Color fundus image — 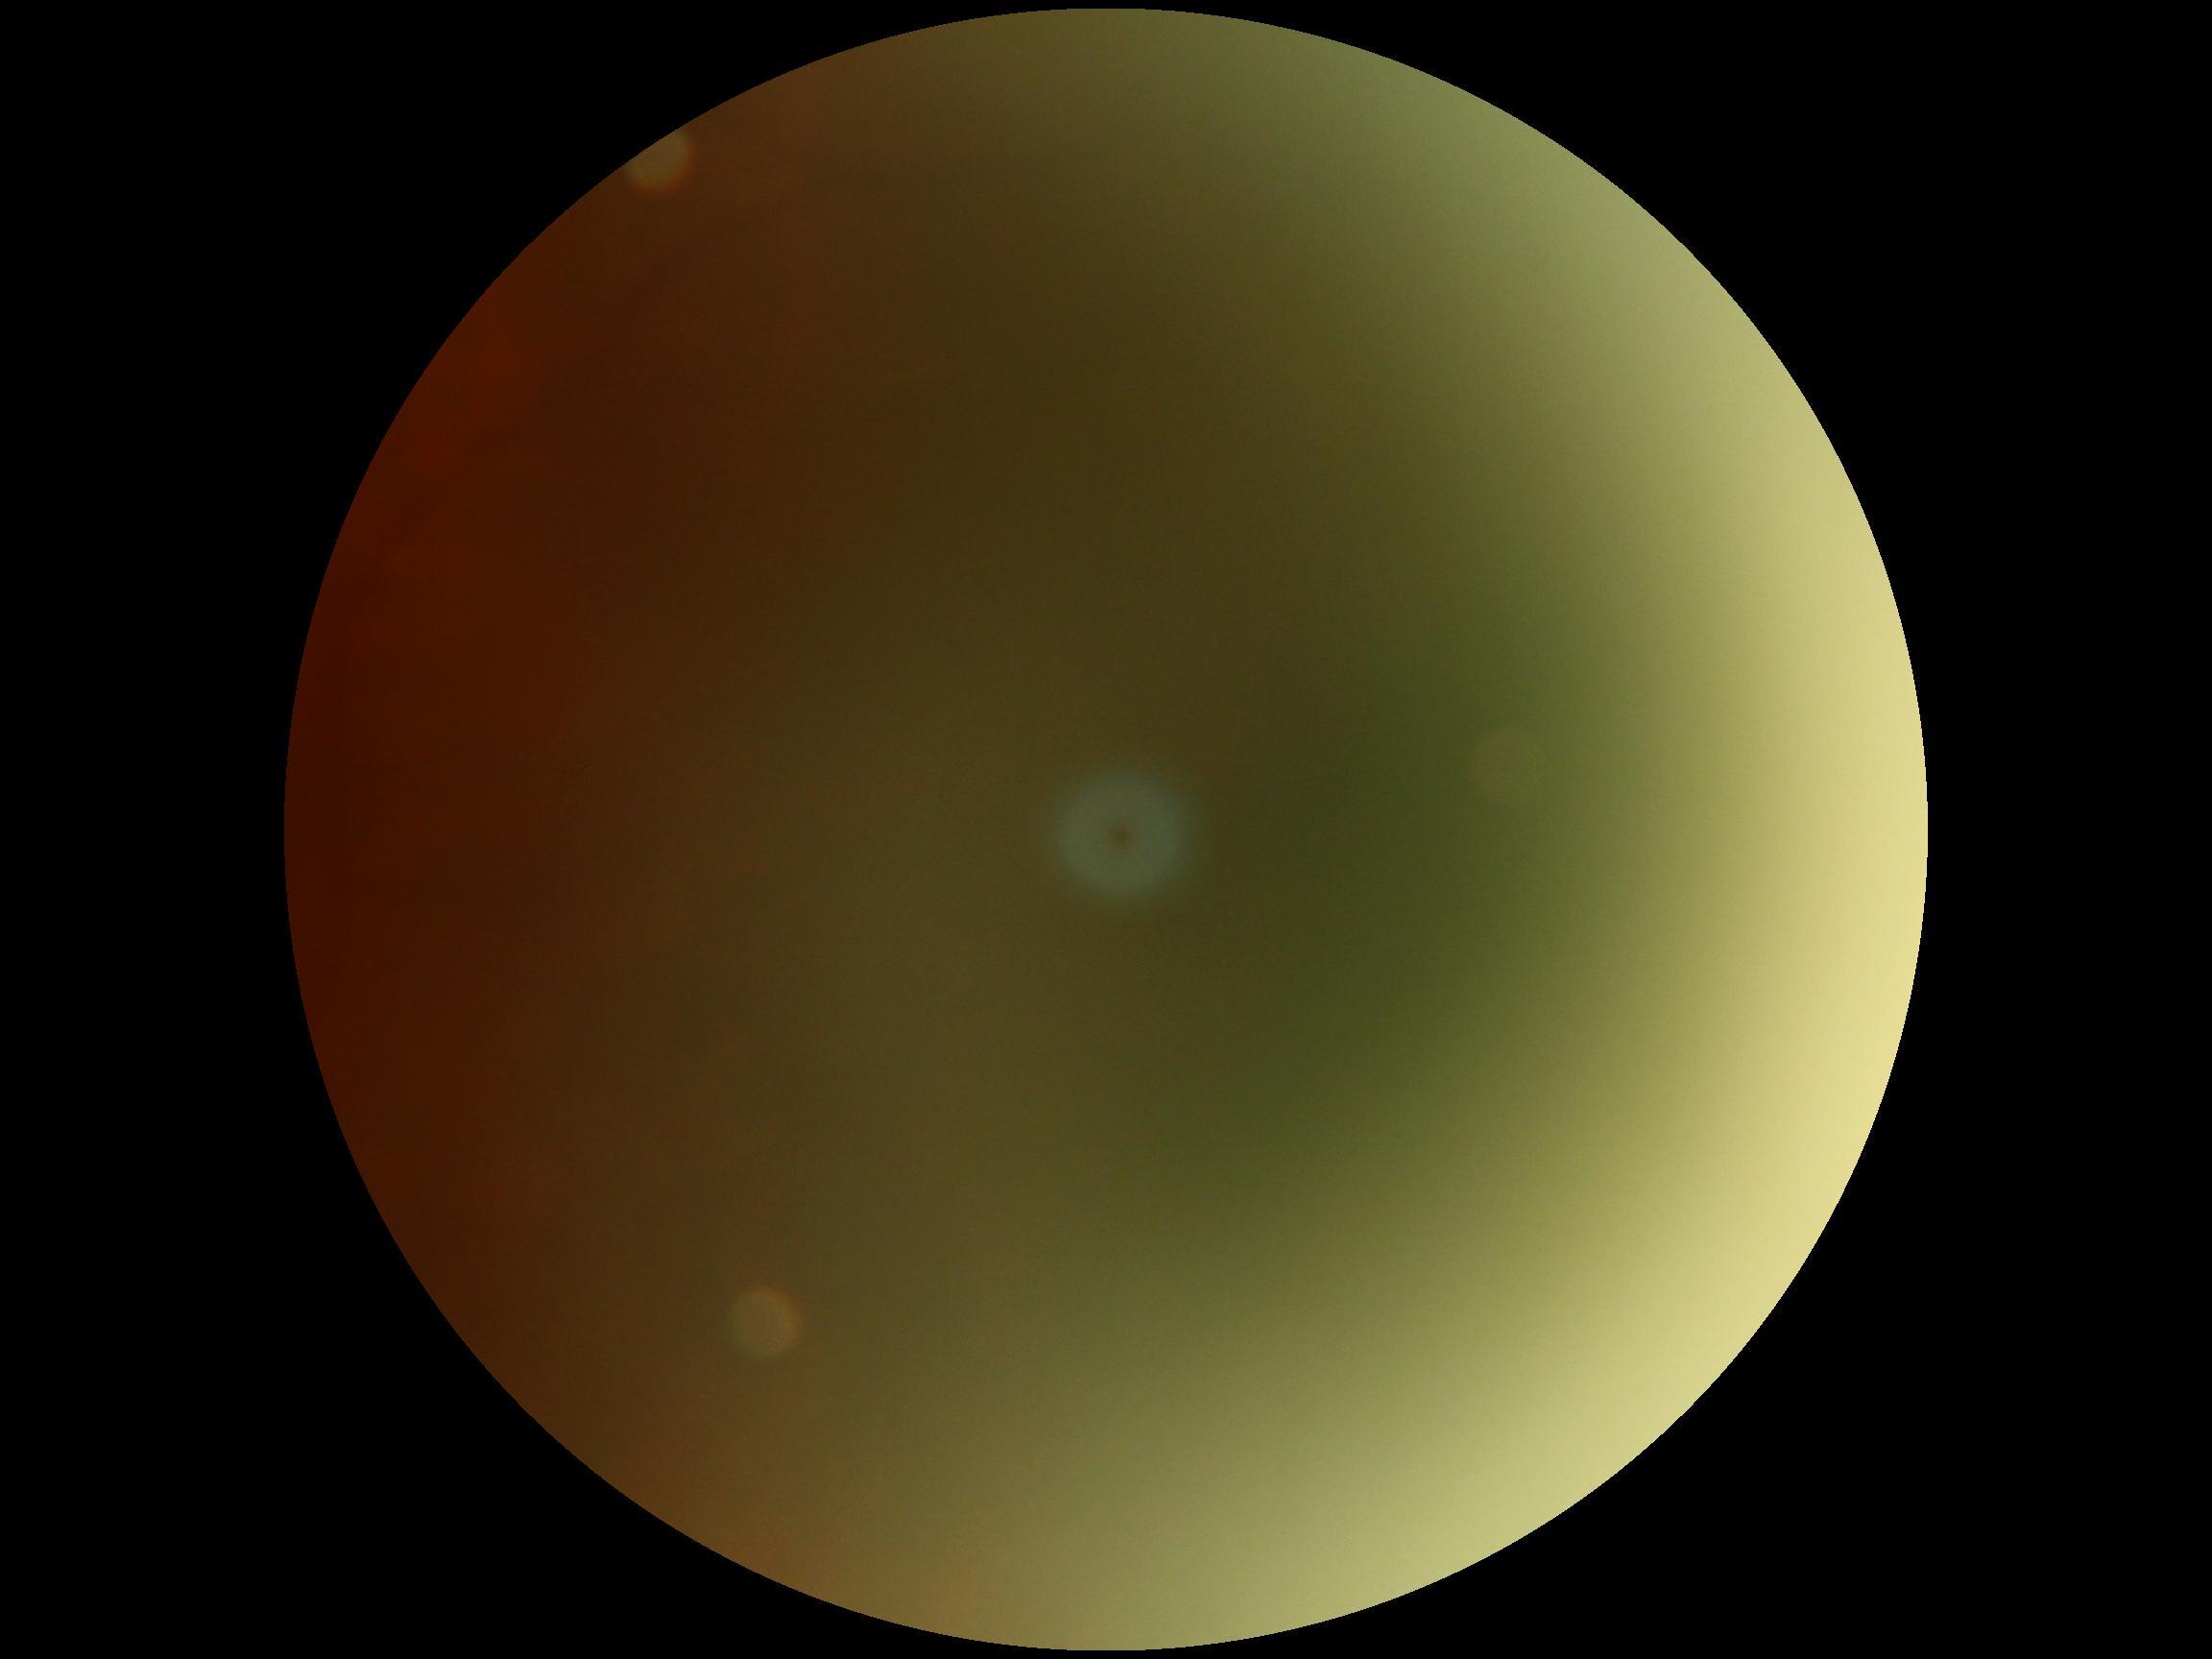

Ungradable image — DR severity cannot be determined. Diabetic retinopathy grade: ungradable due to poor image quality.